Nonmydriatic fundus photograph. 45° field of view. Retinal fundus photograph.
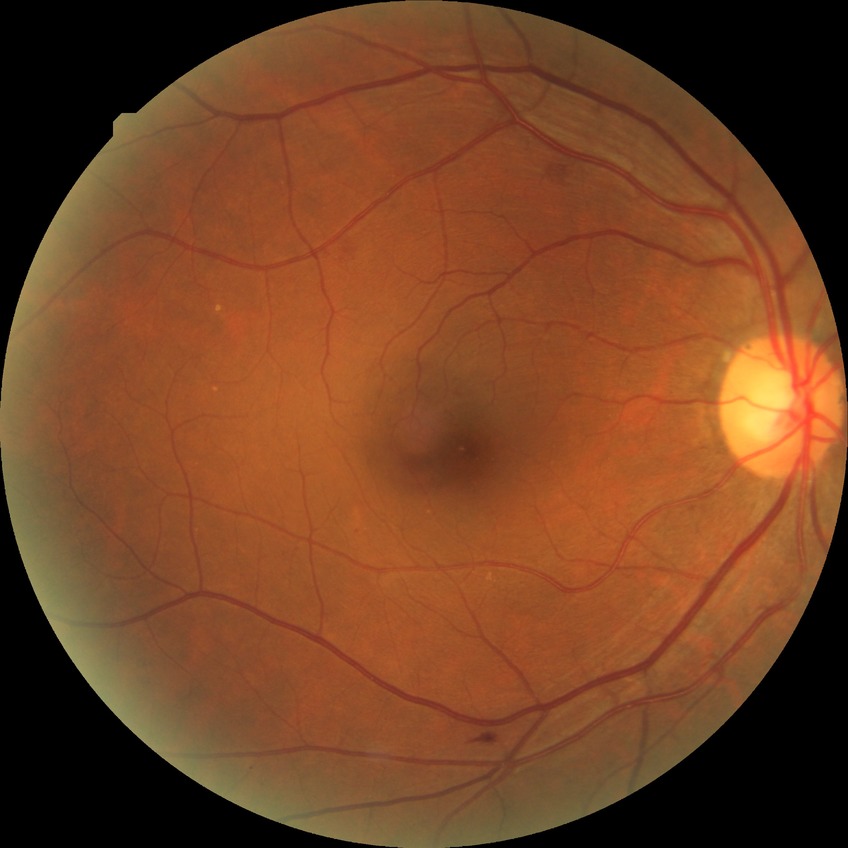

diabetic retinopathy (DR): SDR (simple diabetic retinopathy).